45 degree fundus photograph; 848 x 848 pixels; posterior pole photograph — 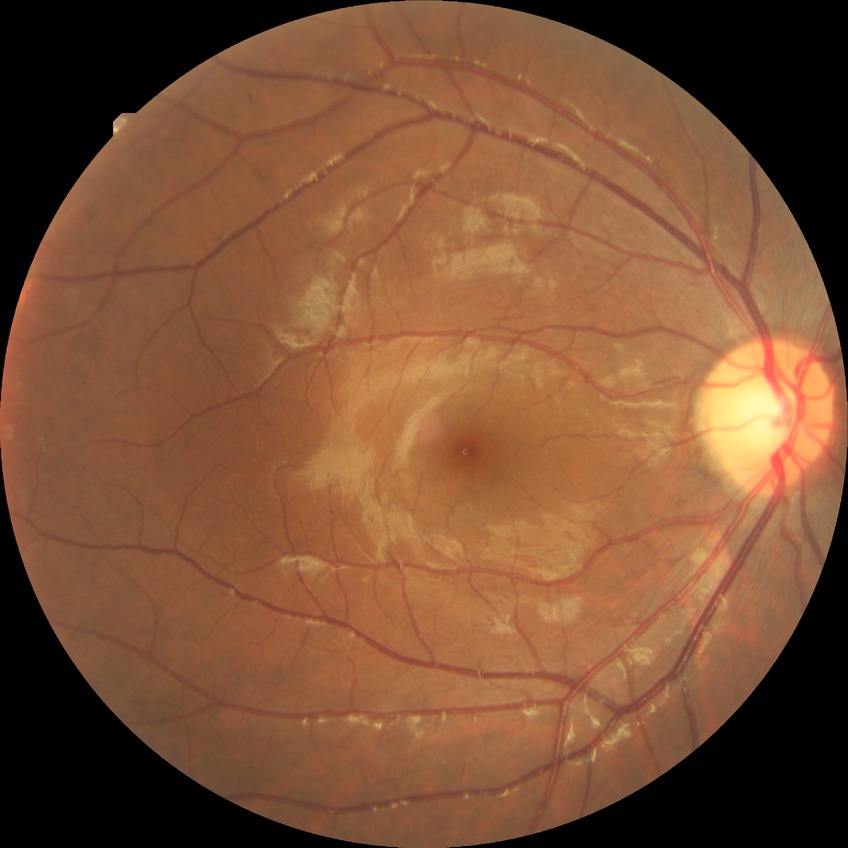

DR severity is SDR.
The retinopathy is classified as non-proliferative diabetic retinopathy.